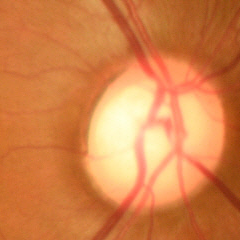
Optic nerve head appearance consistent with early-stage glaucoma. Defined as glaucomatous retinal nerve fiber layer defects on red-free fundus photography without visual field defects.